45-degree field of view — 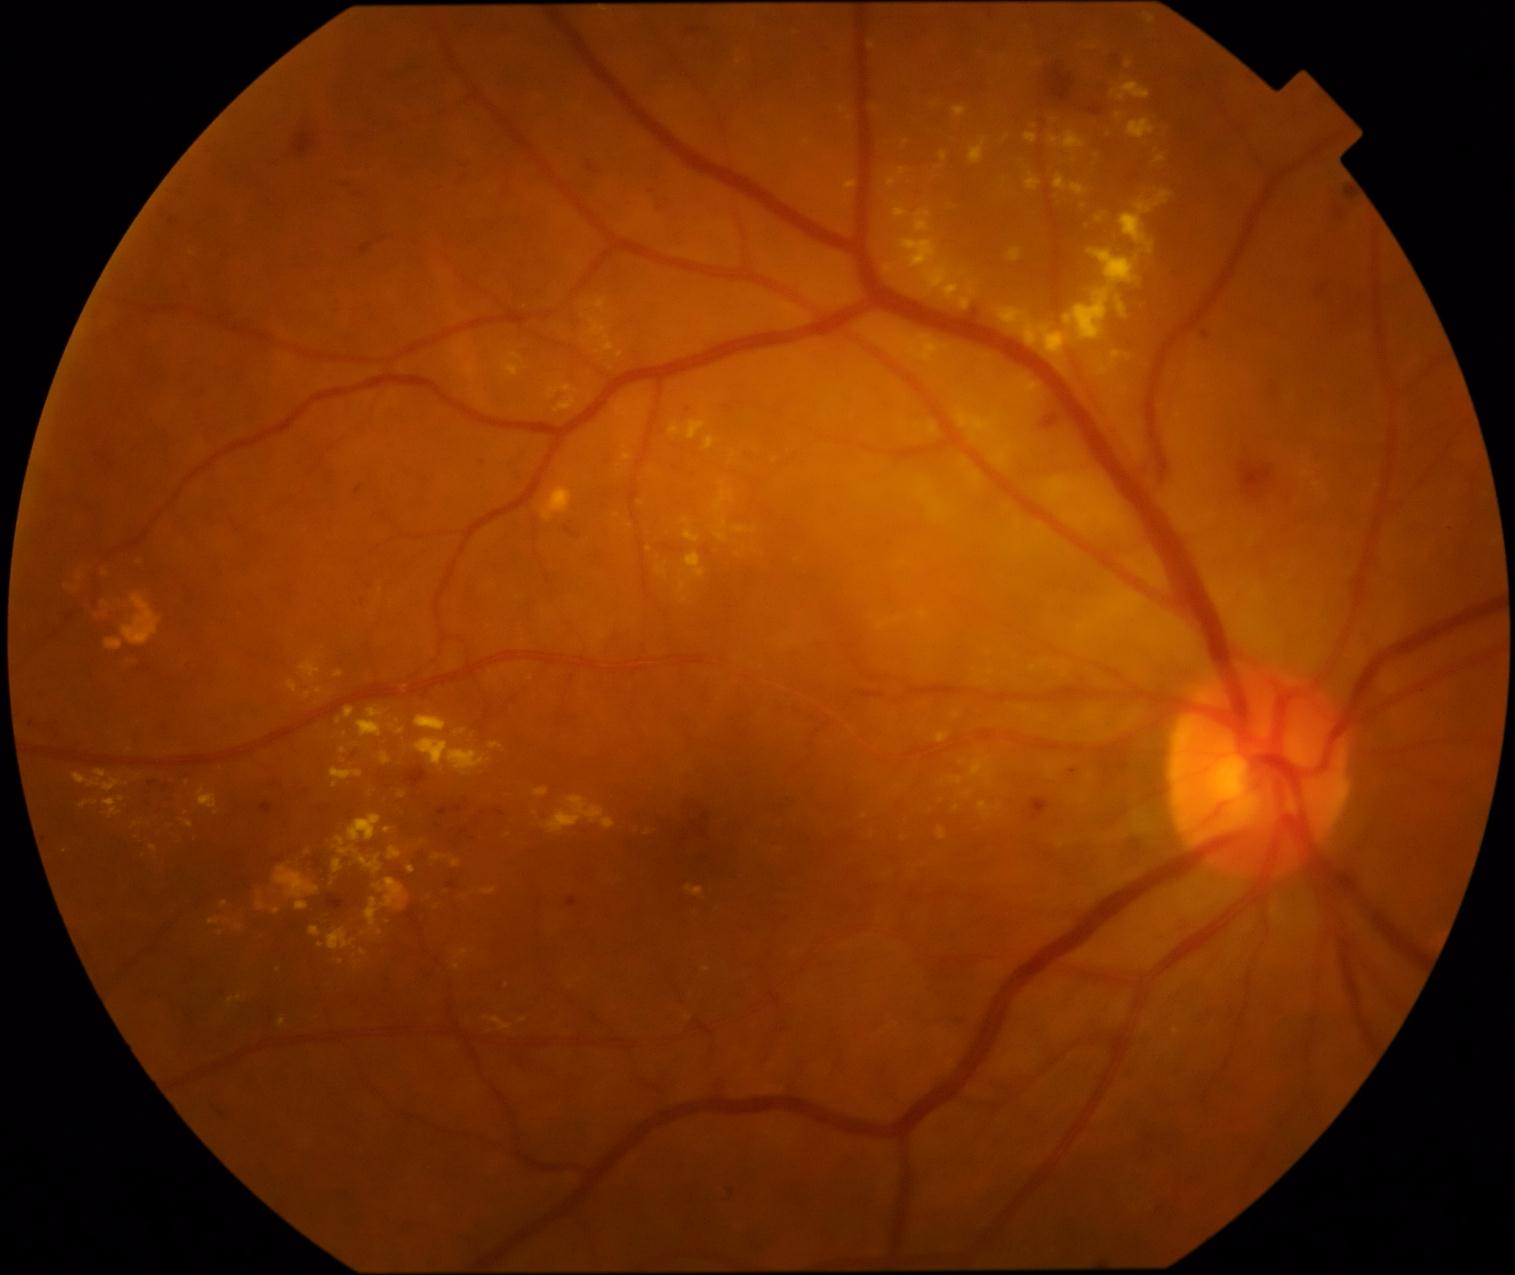 Findings:
– diabetic retinopathy grade: 2 (moderate NPDR)
– DR class: non-proliferative diabetic retinopathy